848x848px, camera: NIDEK AFC-230: 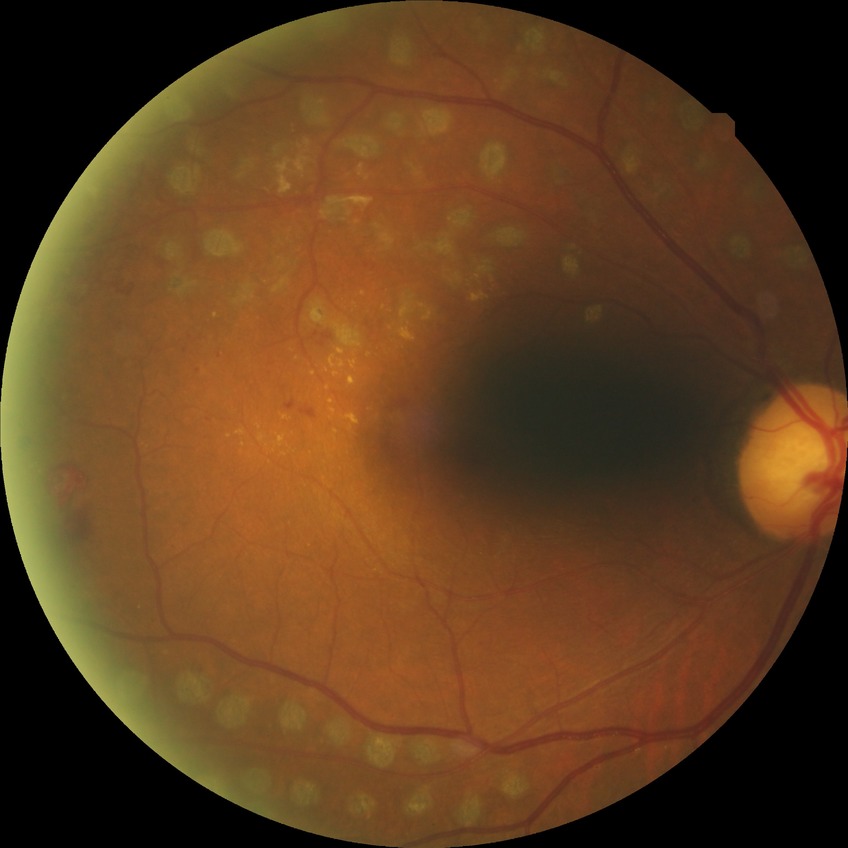
davis_grade: proliferative diabetic retinopathy